Non-mydriatic fundus camera
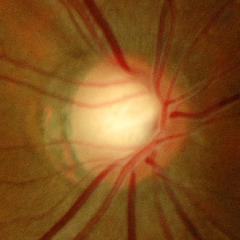 Q: What stage of glaucoma is present?
A: Yes — early glaucoma.